1240x1240 · wide-field fundus image from infant ROP screening:
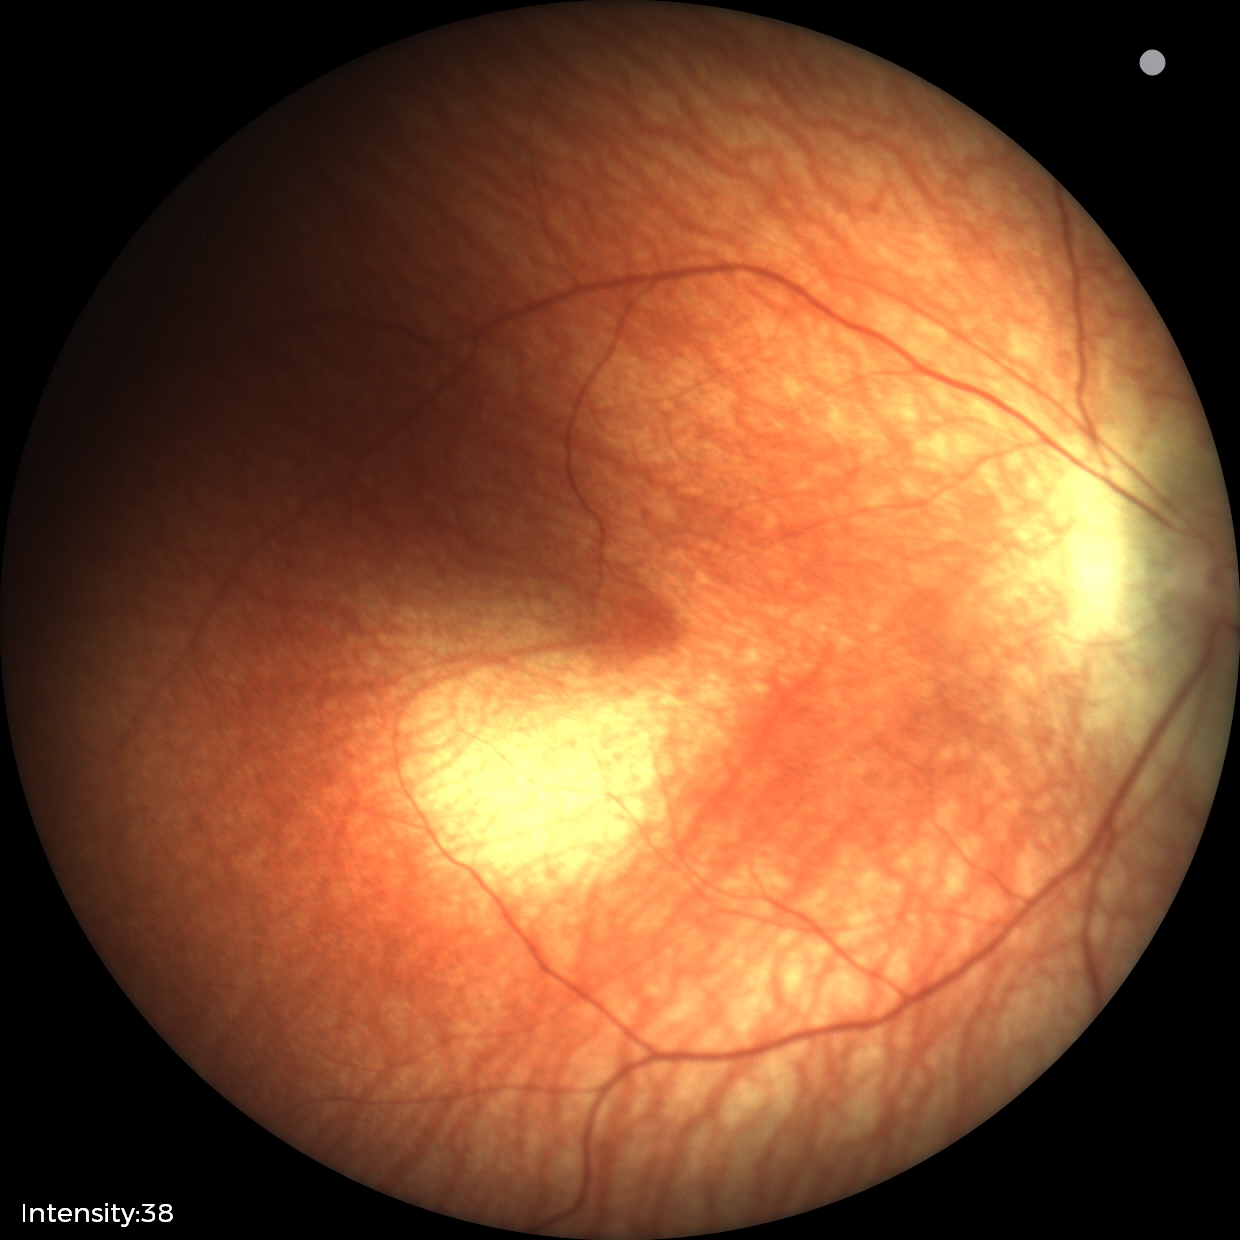
Impression: normal fundus examination.